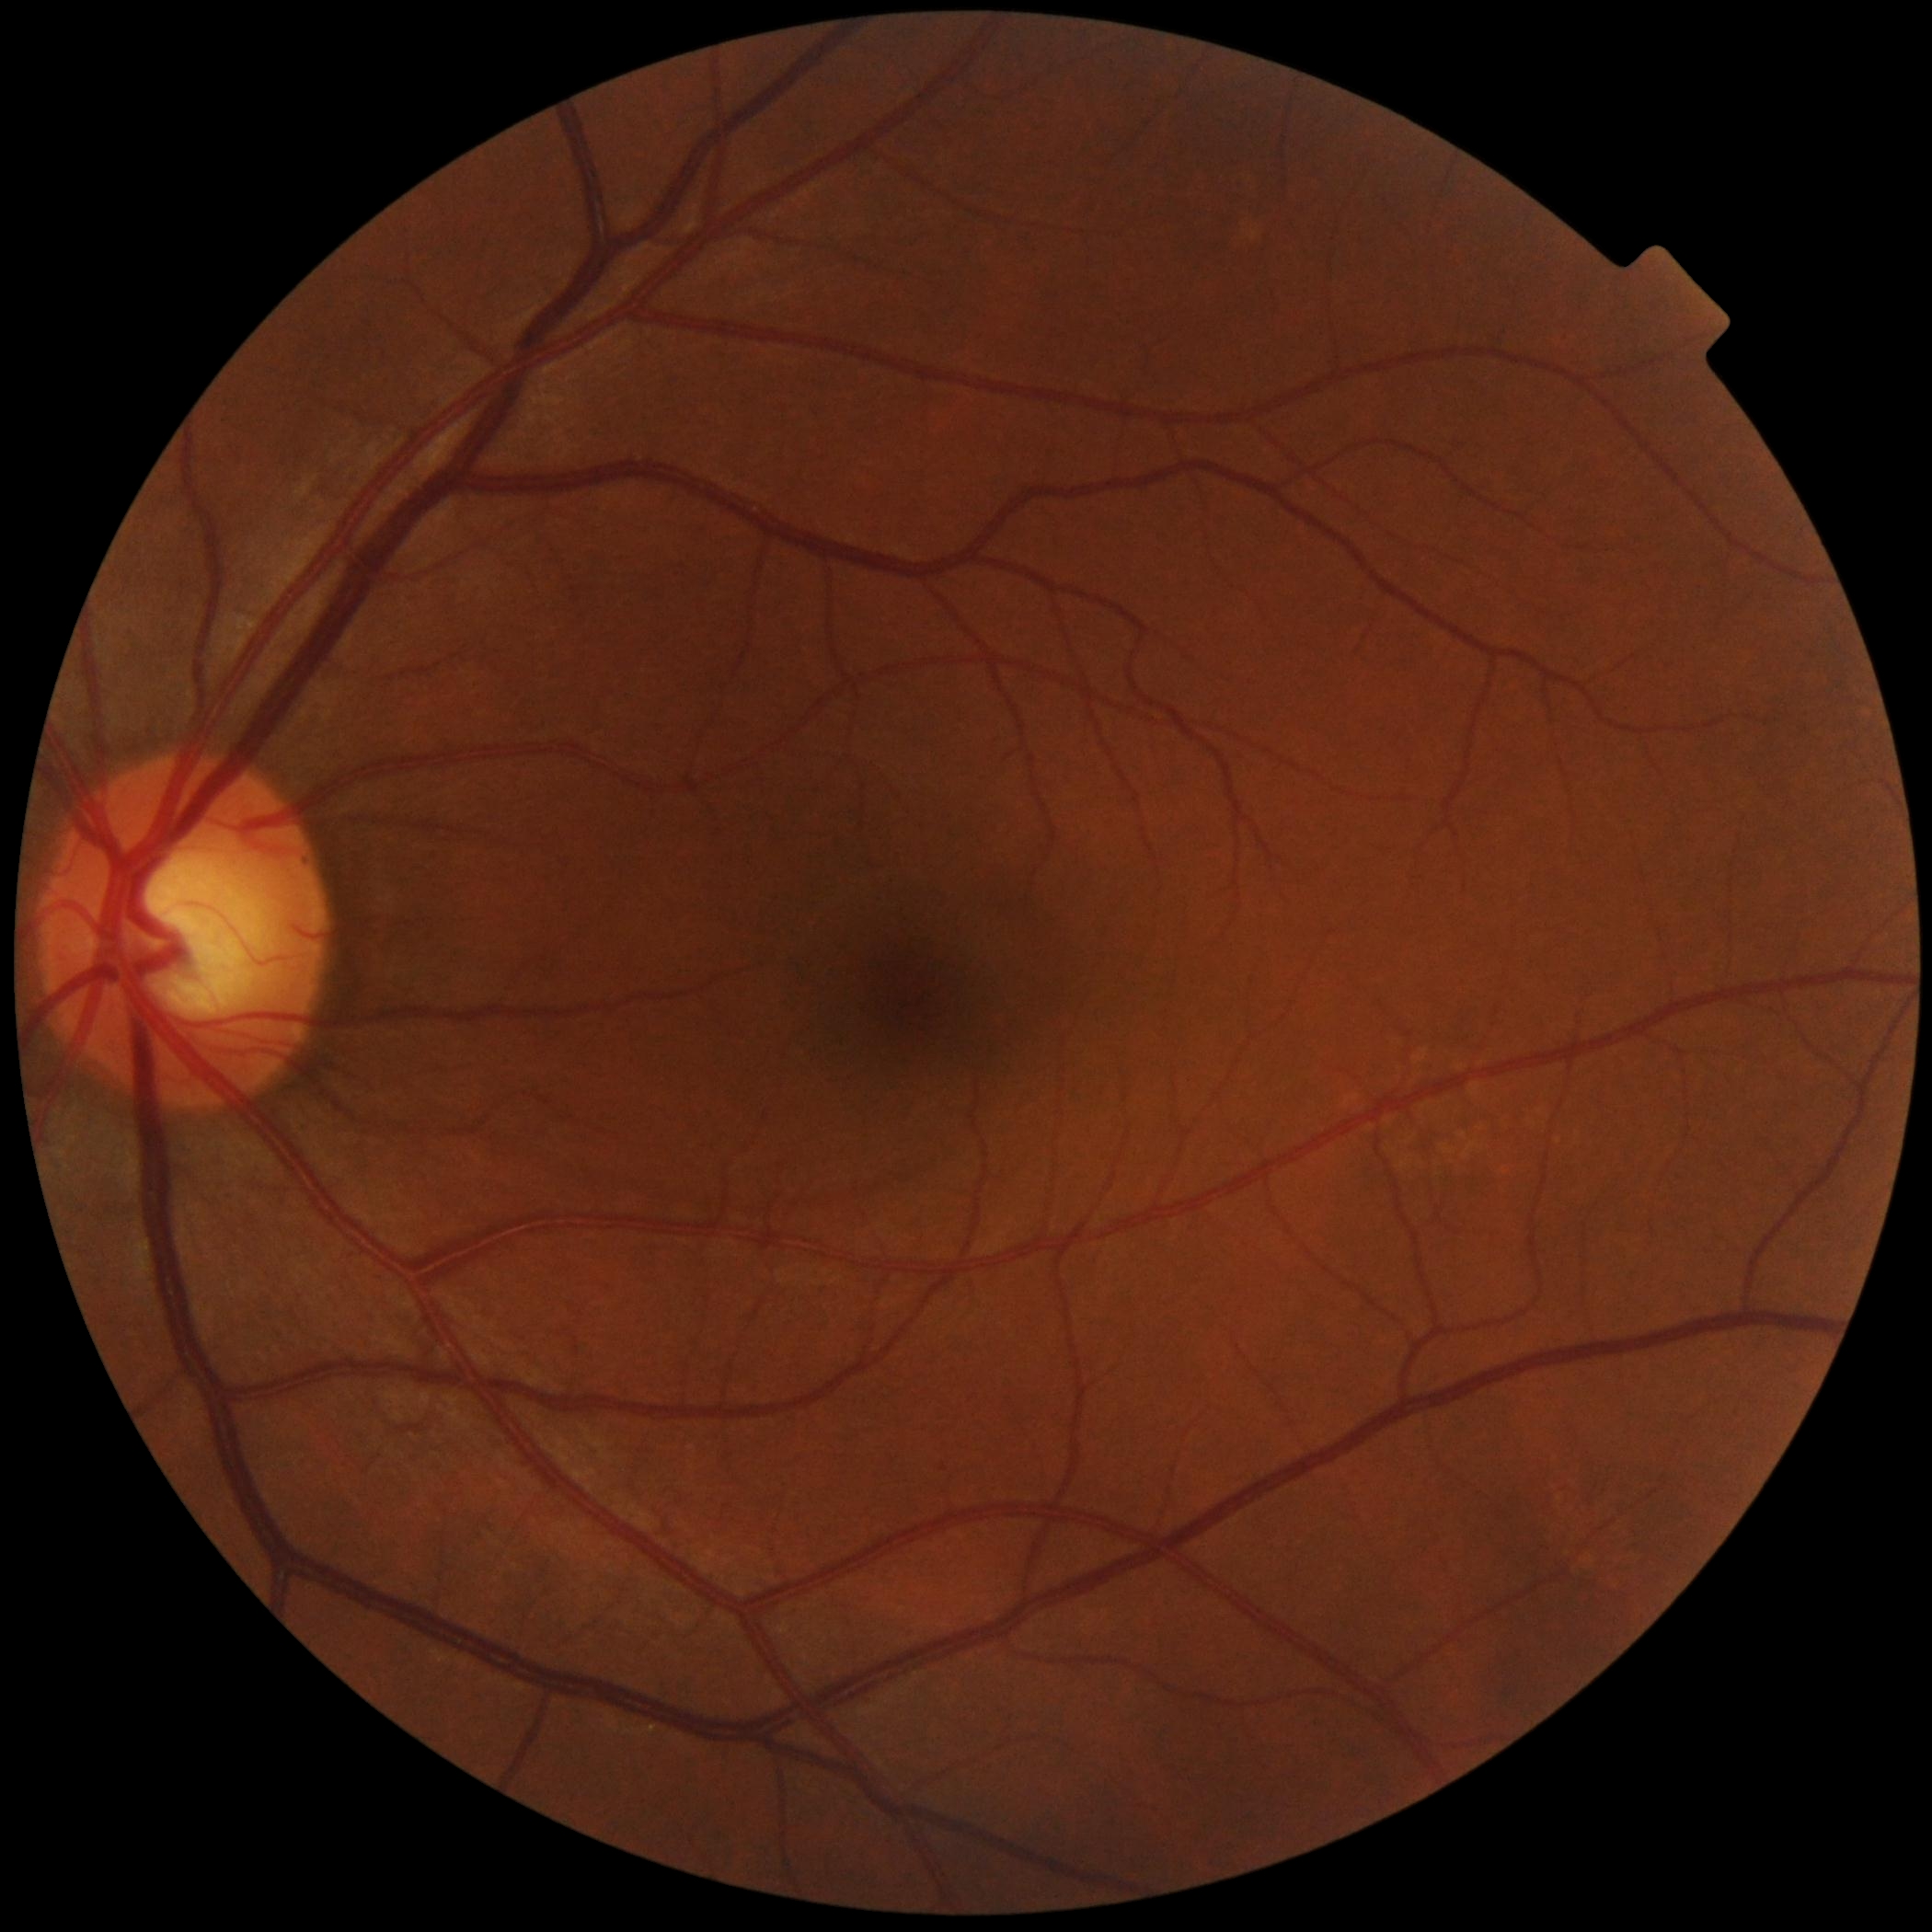
diabetic retinopathy (DR): grade 0 (no apparent retinopathy).